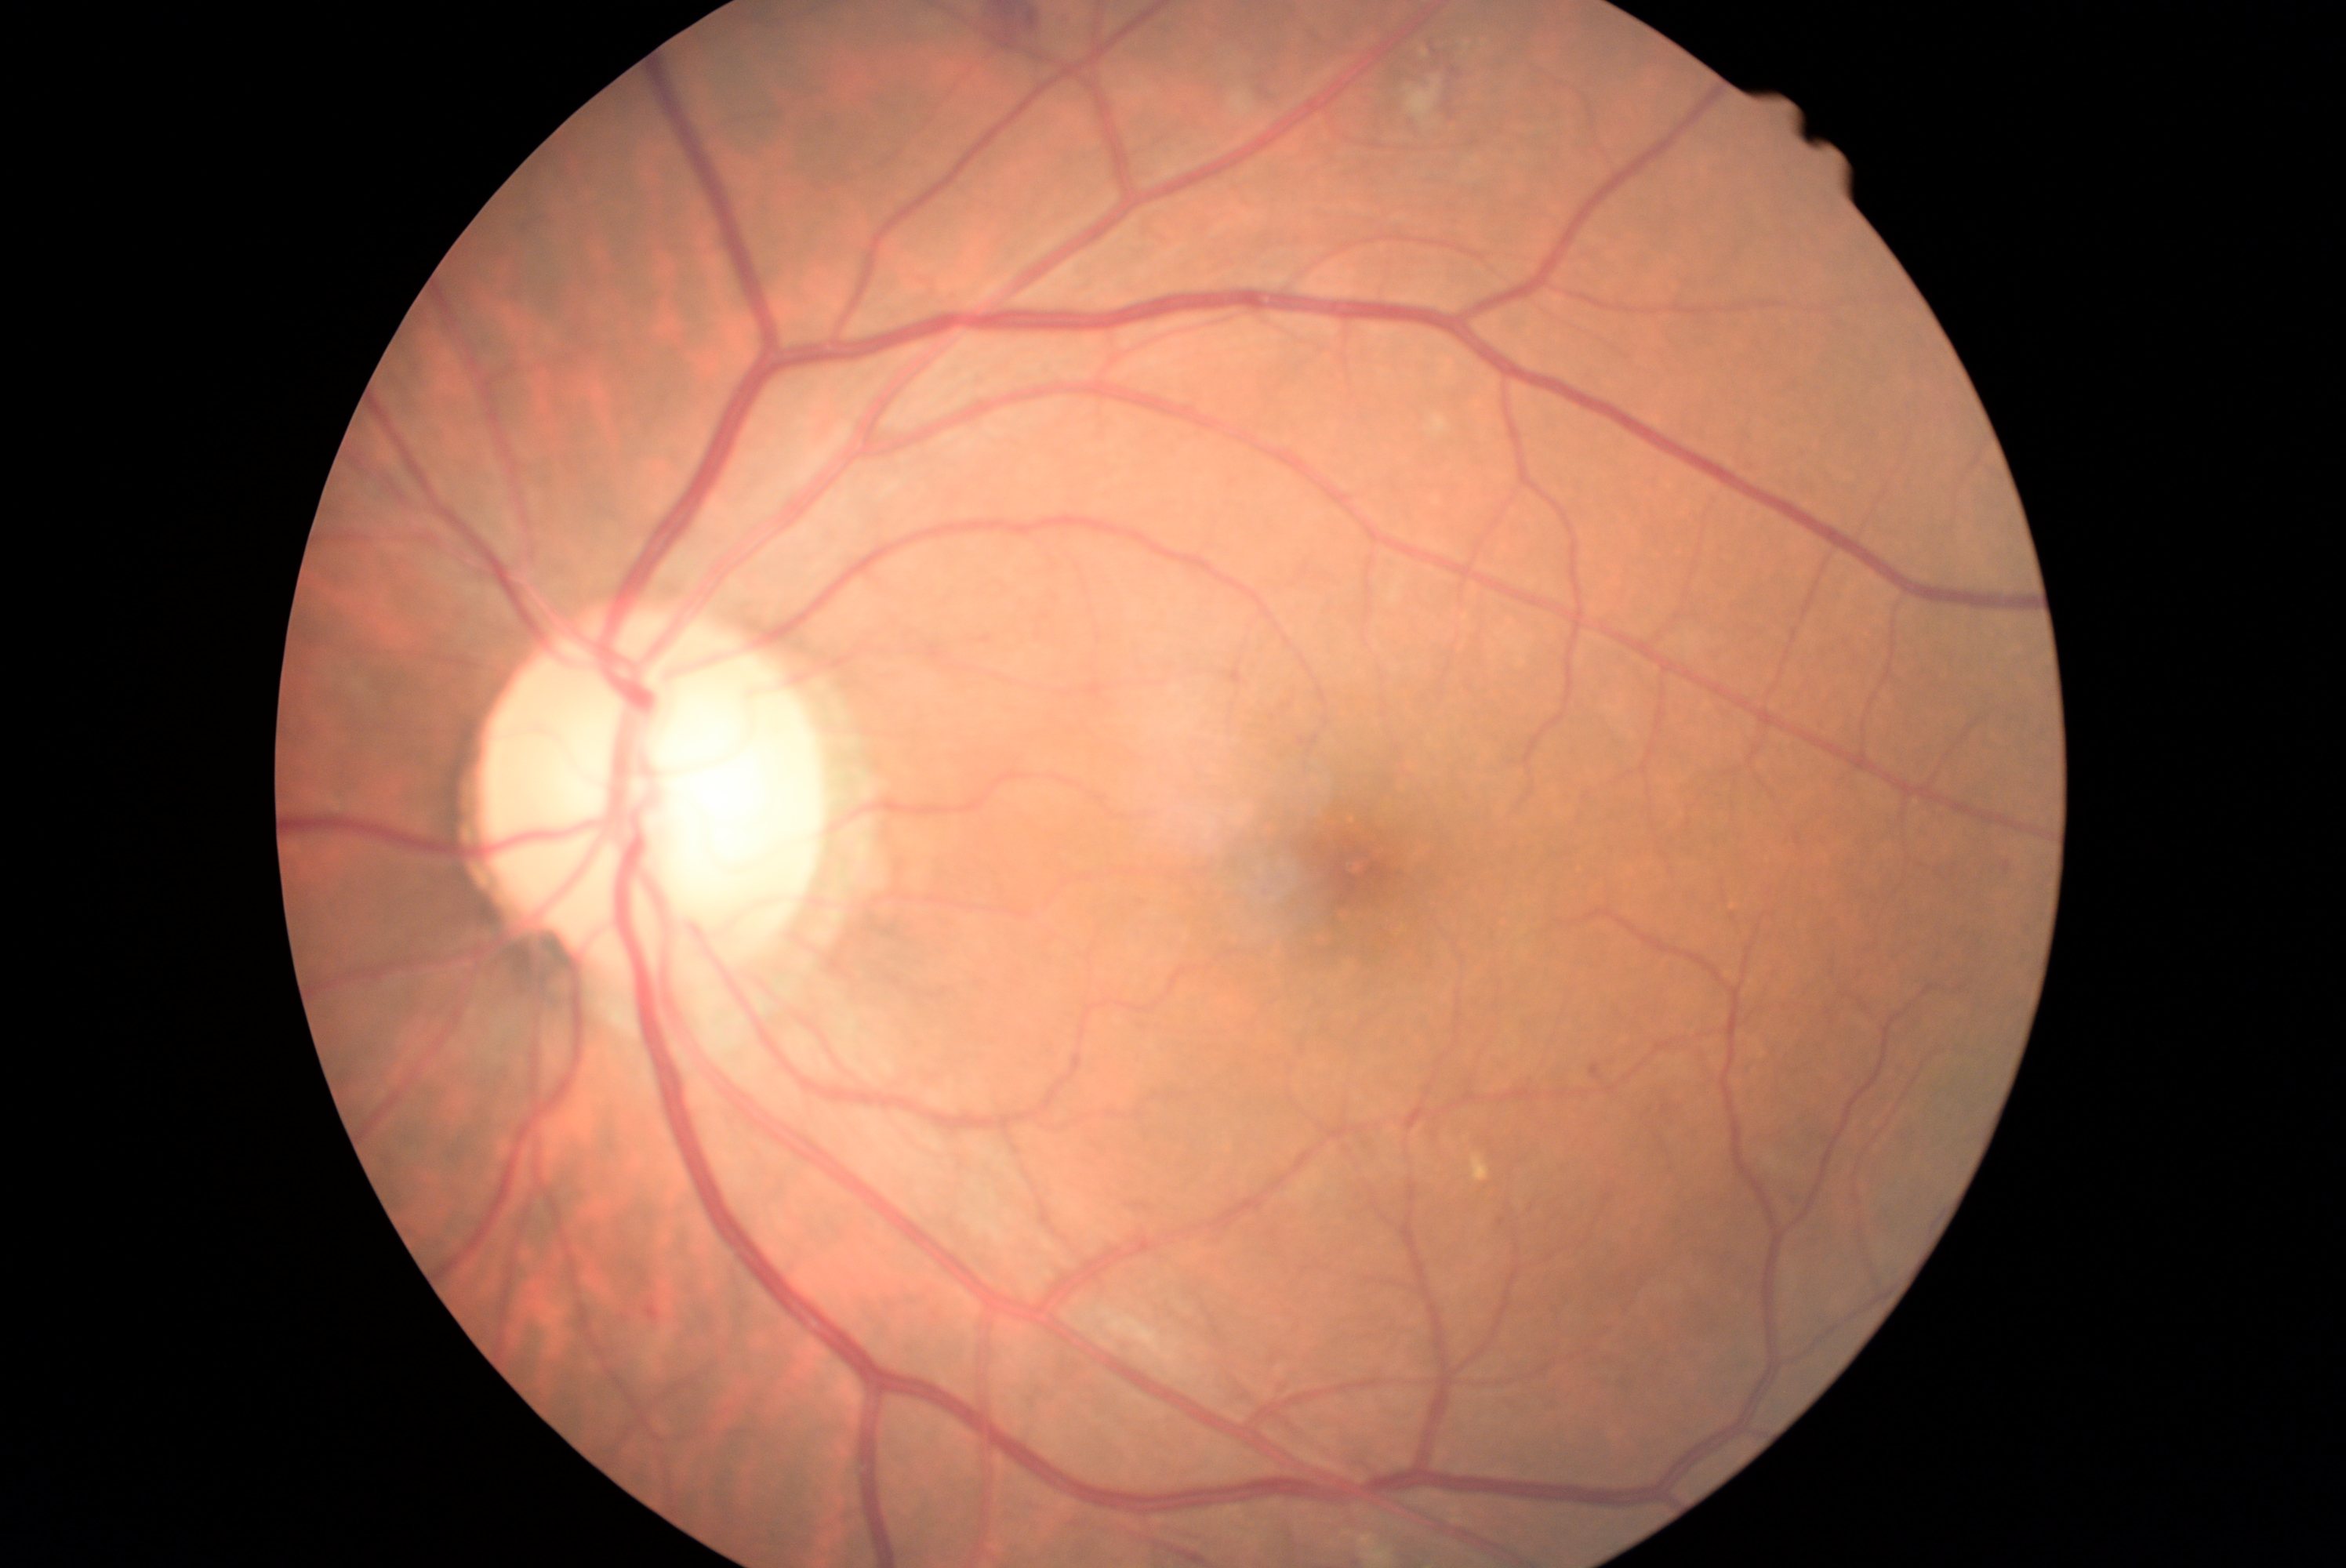 <lesions>
  <dr_grade>2</dr_grade>
  <ex />
  <he>1260 85 1274 98 | 992 9 1039 43 | 1437 49 1456 81 | 1453 95 1459 107</he>
  <he_small>1463, 105</he_small>
  <ma>645 1307 659 1321 | 1498 1218 1506 1227 | 1591 1065 1603 1080</ma>
  <se>1230 92 1257 118 | 1422 49 1429 59 | 1407 78 1442 126</se>
</lesions>